45° FOV; retinal fundus photograph.
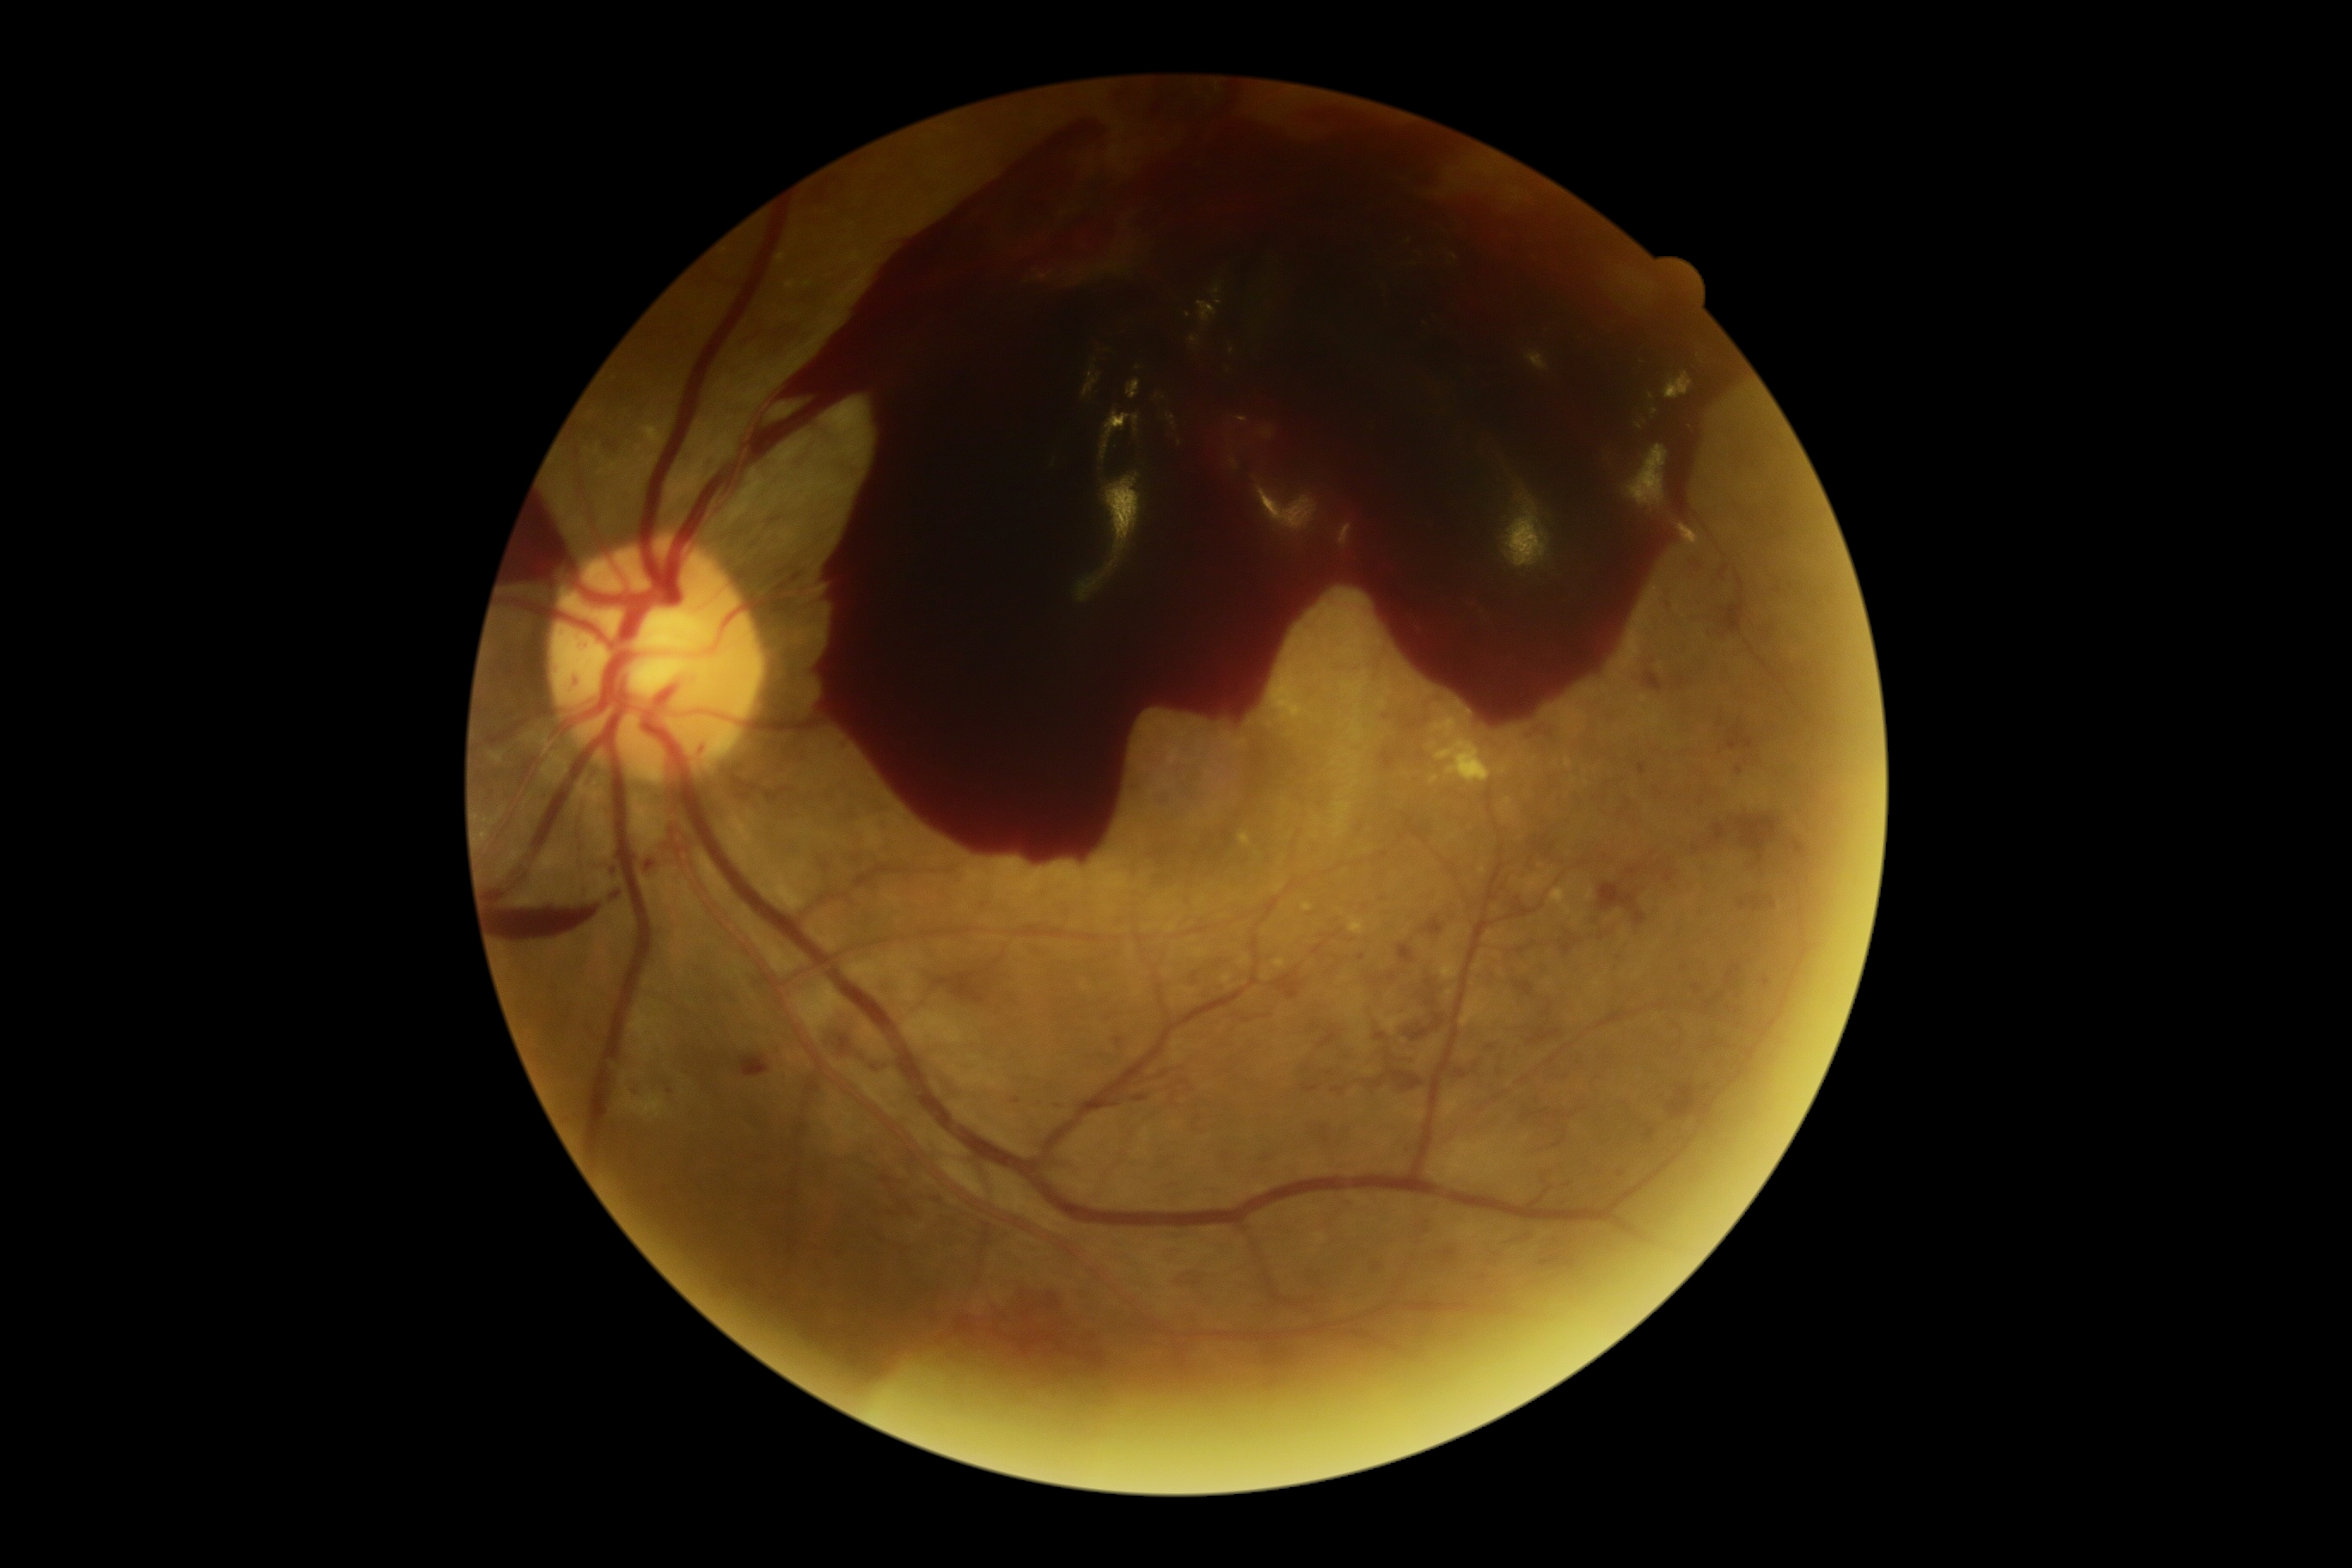 DR severity: 4 — neovascularization and/or vitreous/pre-retinal hemorrhage.